Fundus photo · FOV: 45 degrees · 2352 by 1568 pixels — 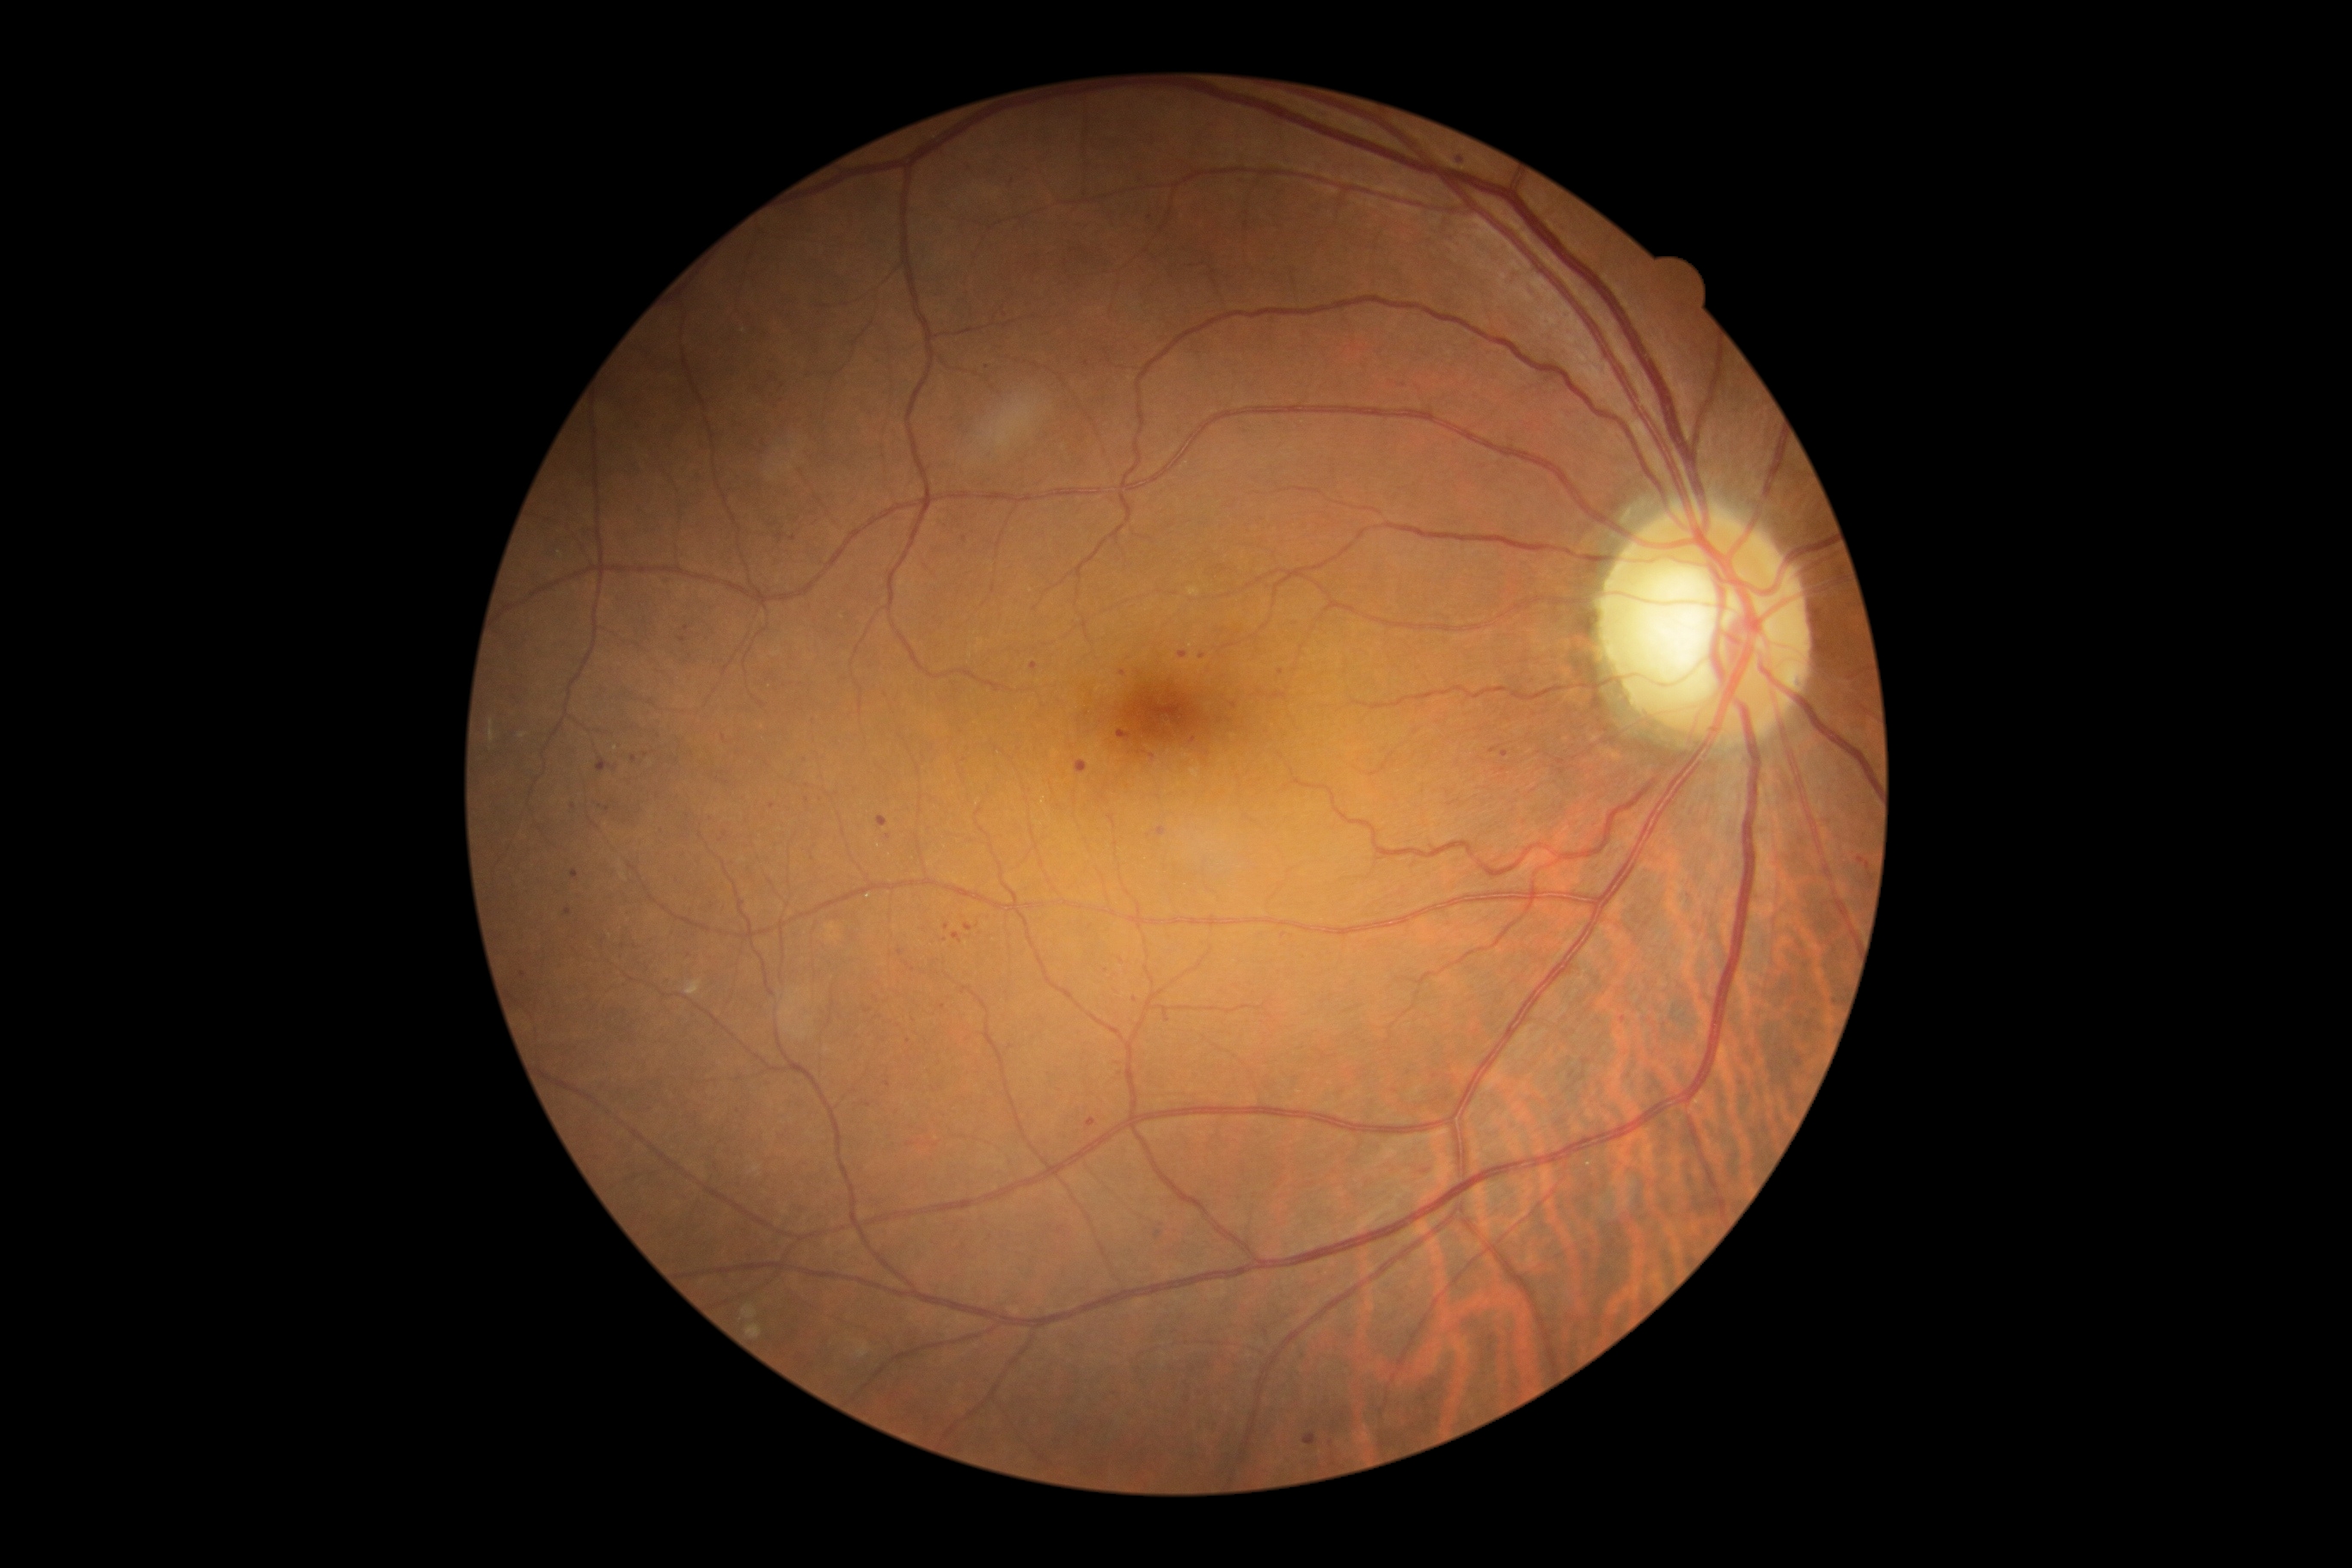

Diabetic retinopathy severity: grade 1
A subset of detected lesions:
- microaneurysms (more not shown): [x1=630, y1=756, x2=637, y2=764] | [x1=1424, y1=1170, x2=1433, y2=1173] | [x1=1490, y1=745, x2=1502, y2=754] | [x1=1118, y1=733, x2=1127, y2=740] | [x1=952, y1=933, x2=964, y2=945]
- Additional small microaneurysms near 1144, 752 | 808, 801 | 683, 640 | 869, 1012 | 869, 1105 | 726, 784 | 1331, 1443 | 601, 807 | 1194, 740 | 1086, 364 | 876, 999 | 1060, 1230